RetCam wide-field infant fundus image:
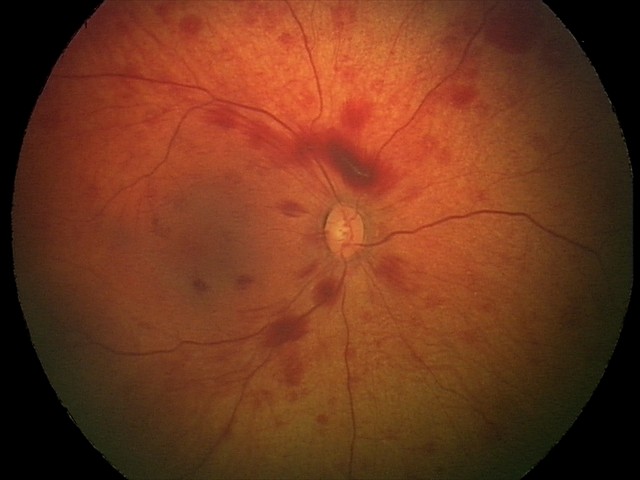

Q: What was the screening finding?
A: retinal hemorrhages